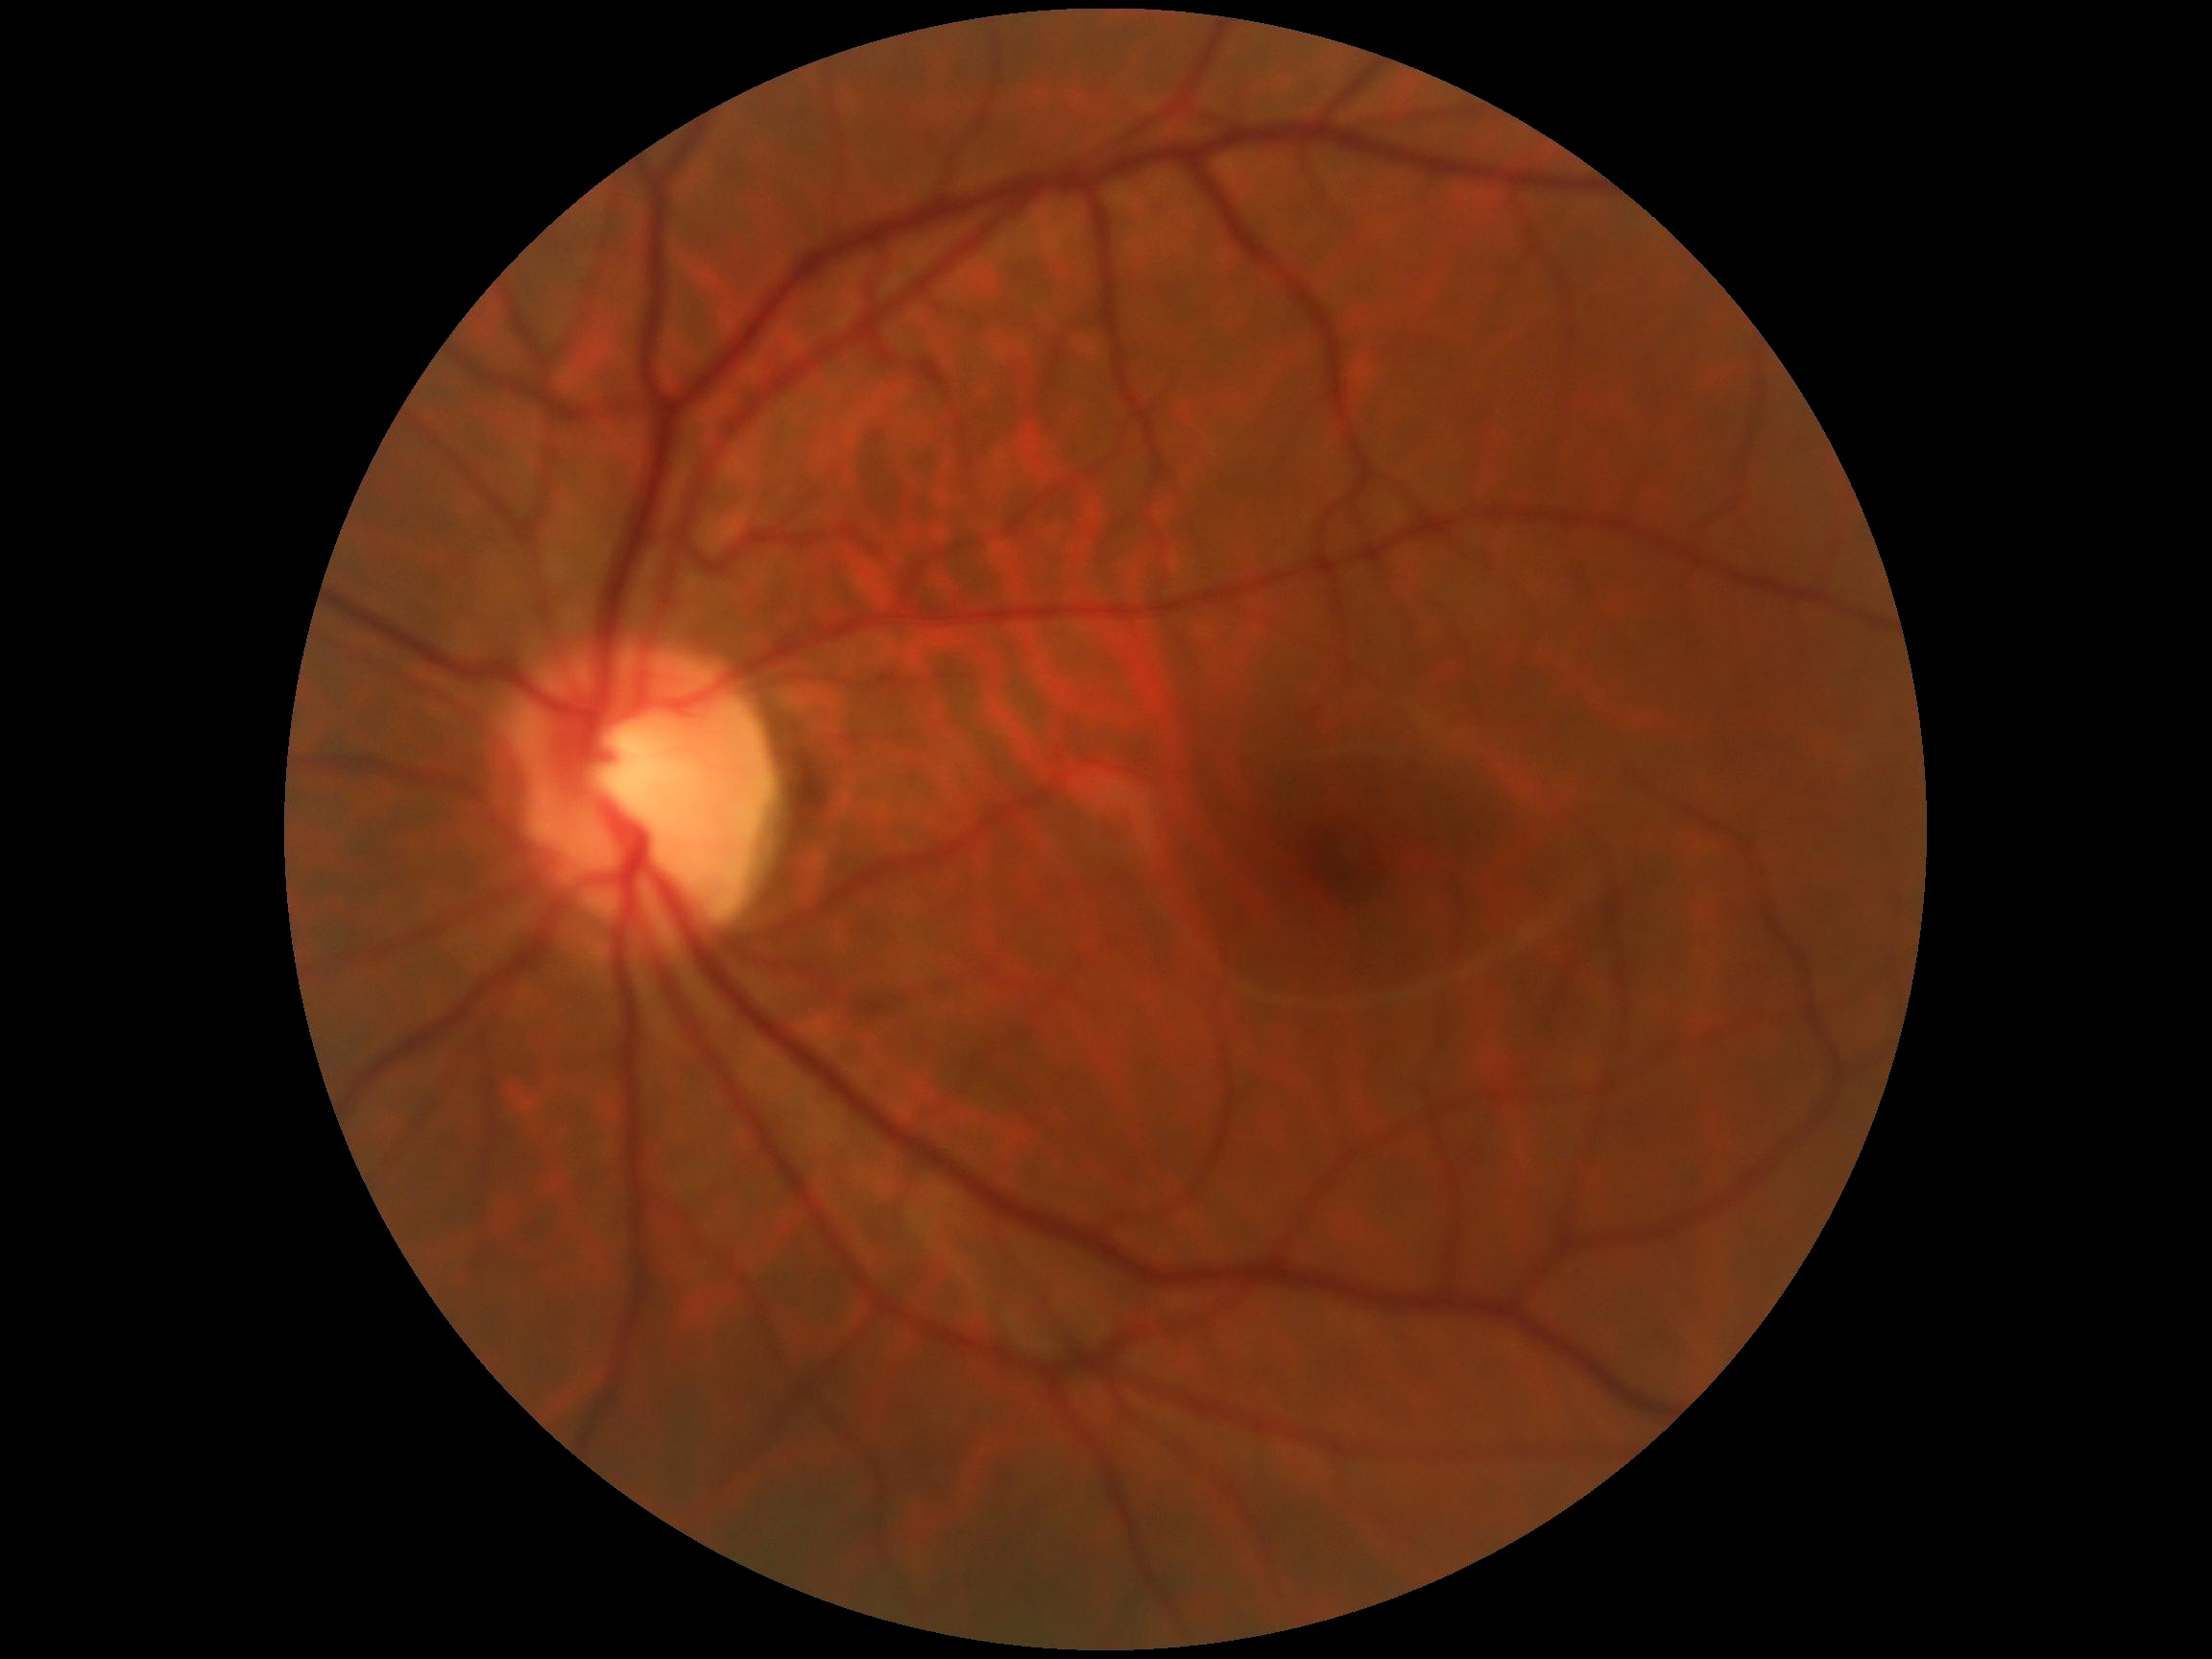 DR severity@grade 0.